Nonmydriatic — 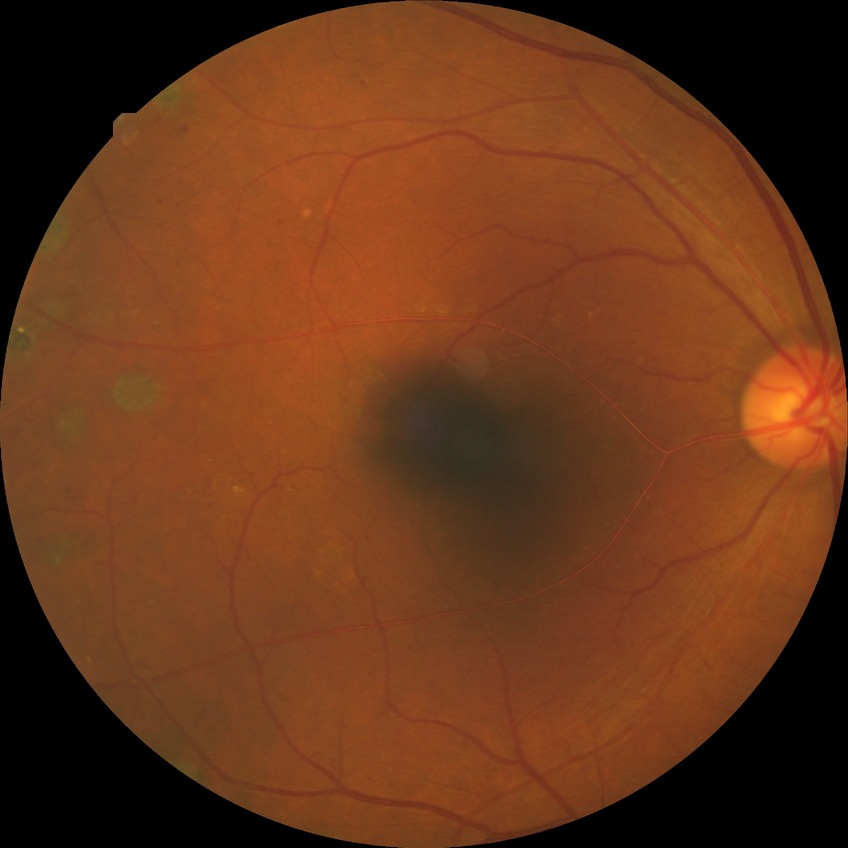 Davis grading is proliferative diabetic retinopathy.